Wide-field retinal mosaic image, FOV: 200 degrees
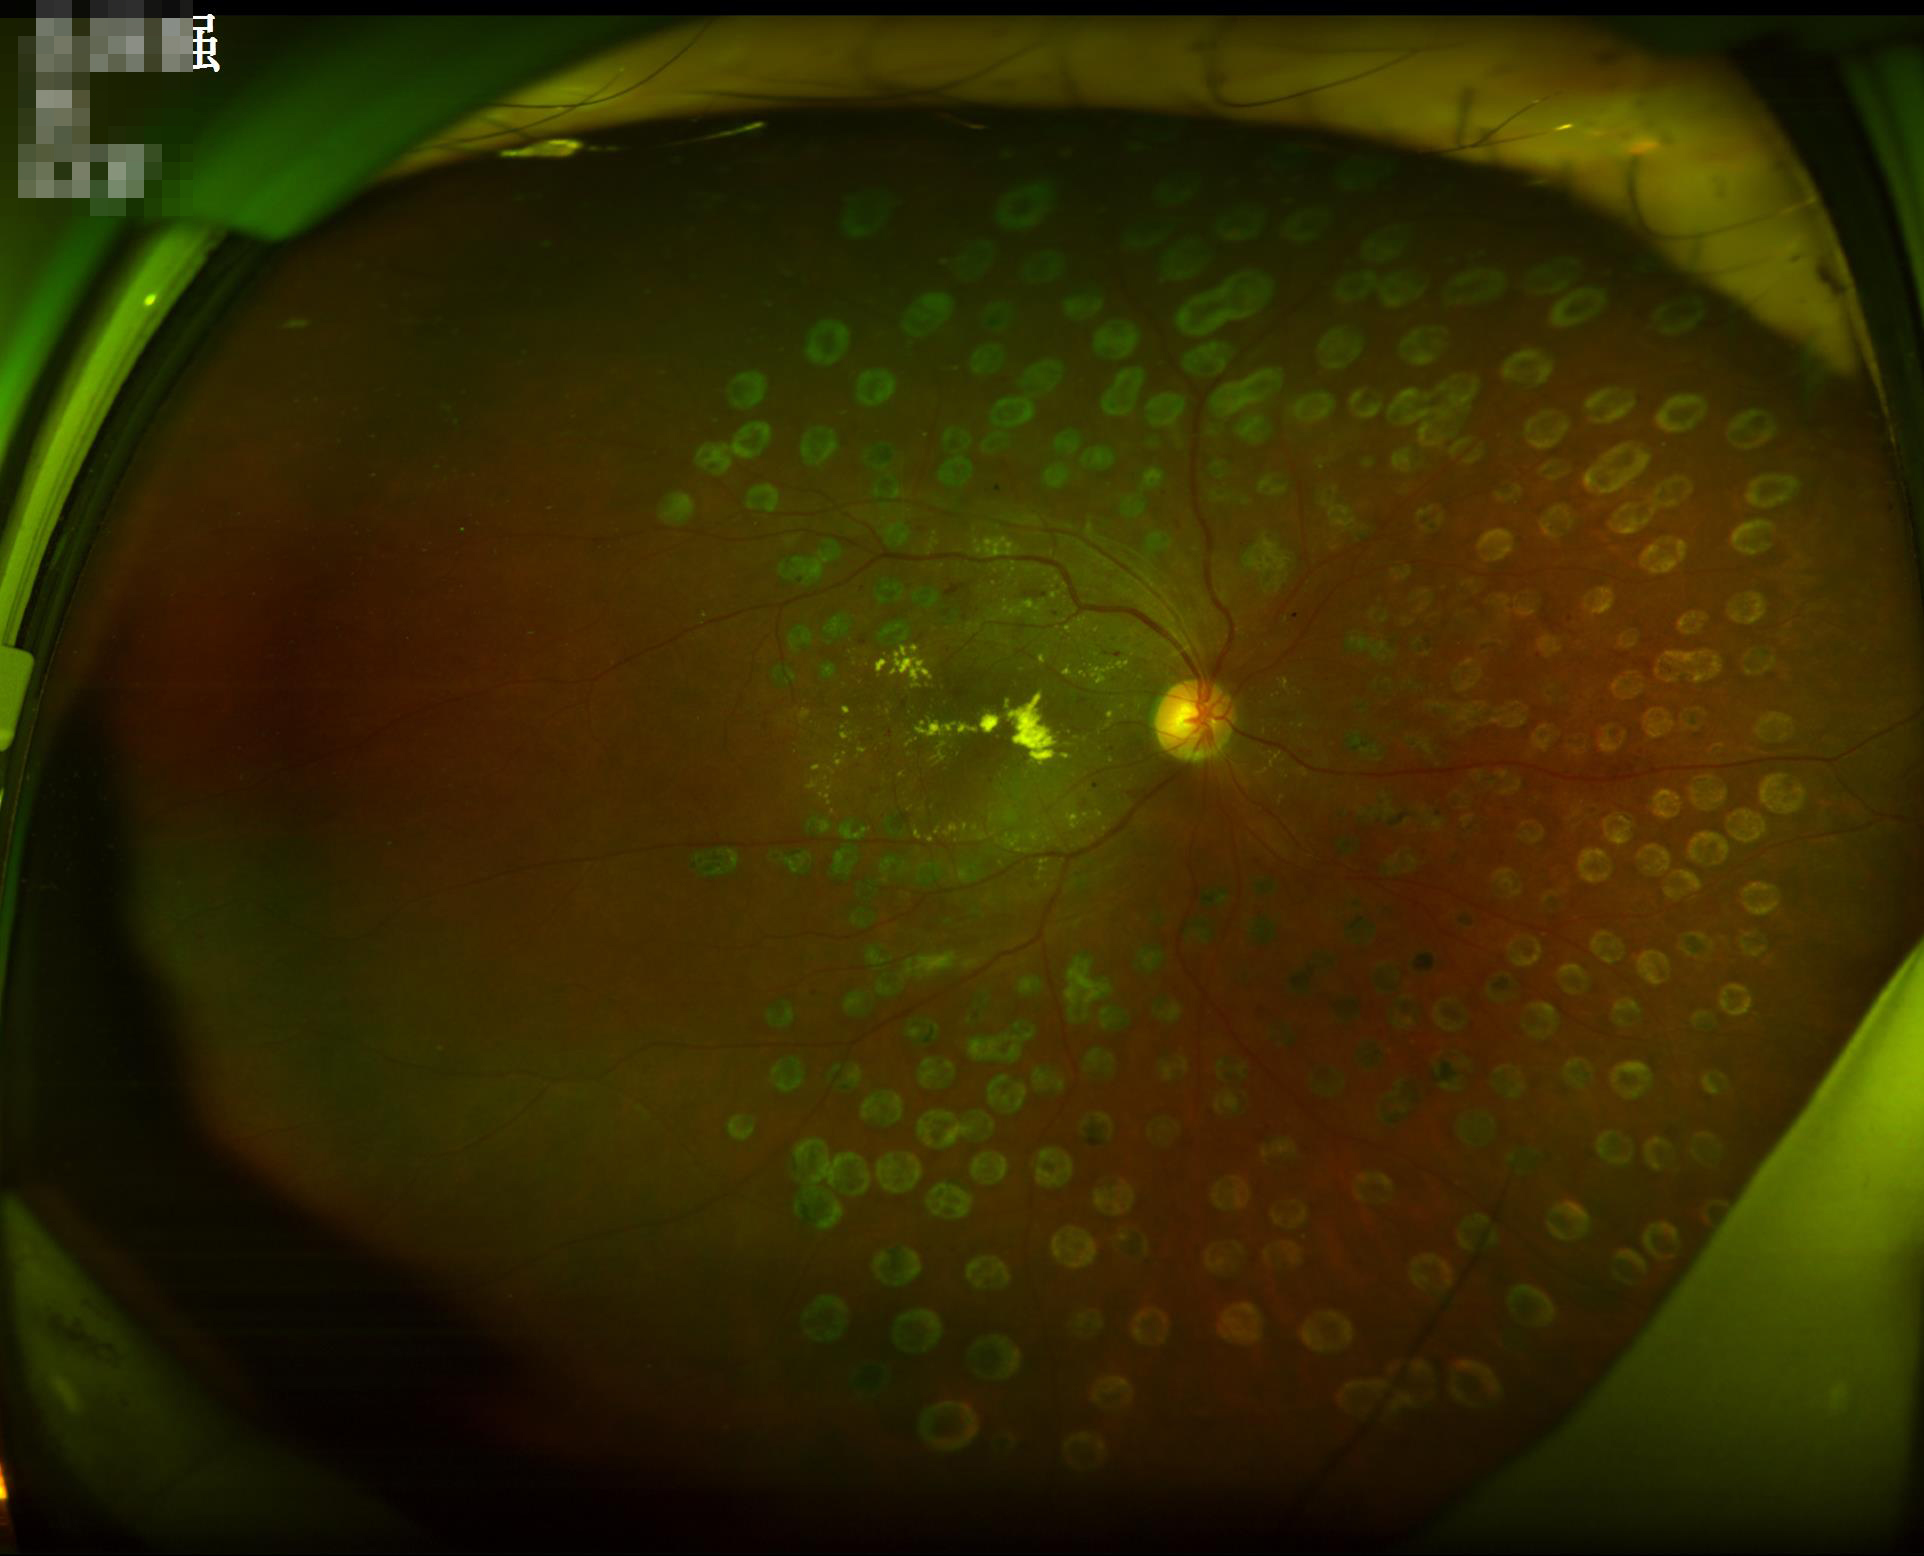 Quality grading:
- illumination: inadequate, with uneven exposure or color distortion
- sharpness: clear with no noticeable blur
- overall: good and suitable for diagnostic use
- contrast: vessels and details readily distinguishable